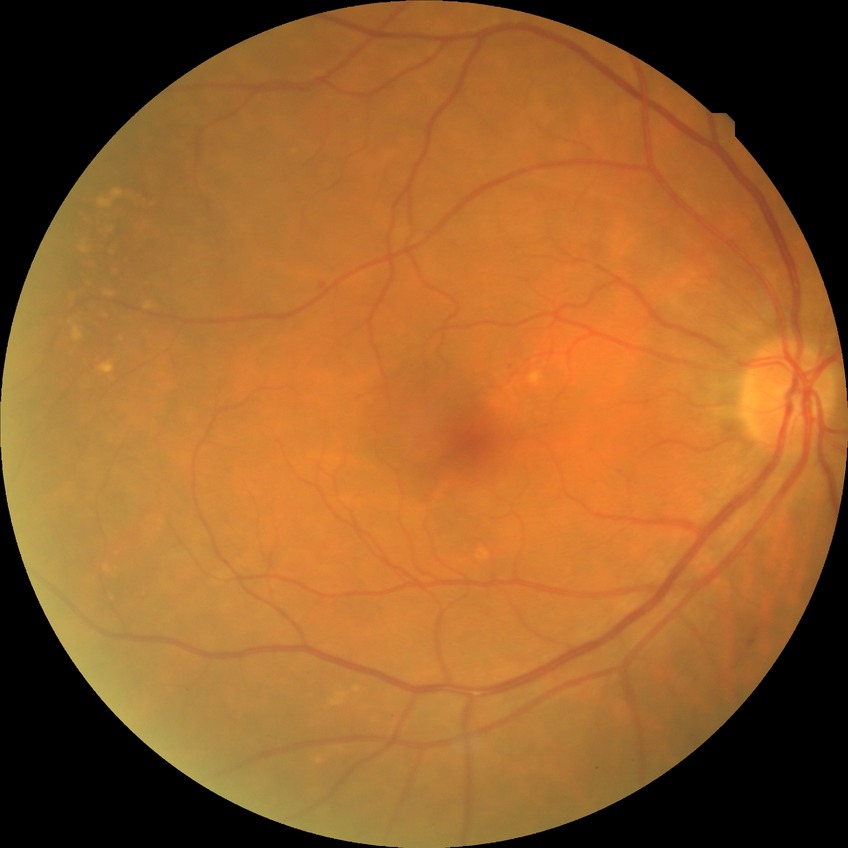
Diabetic retinopathy (DR) is SDR (simple diabetic retinopathy).